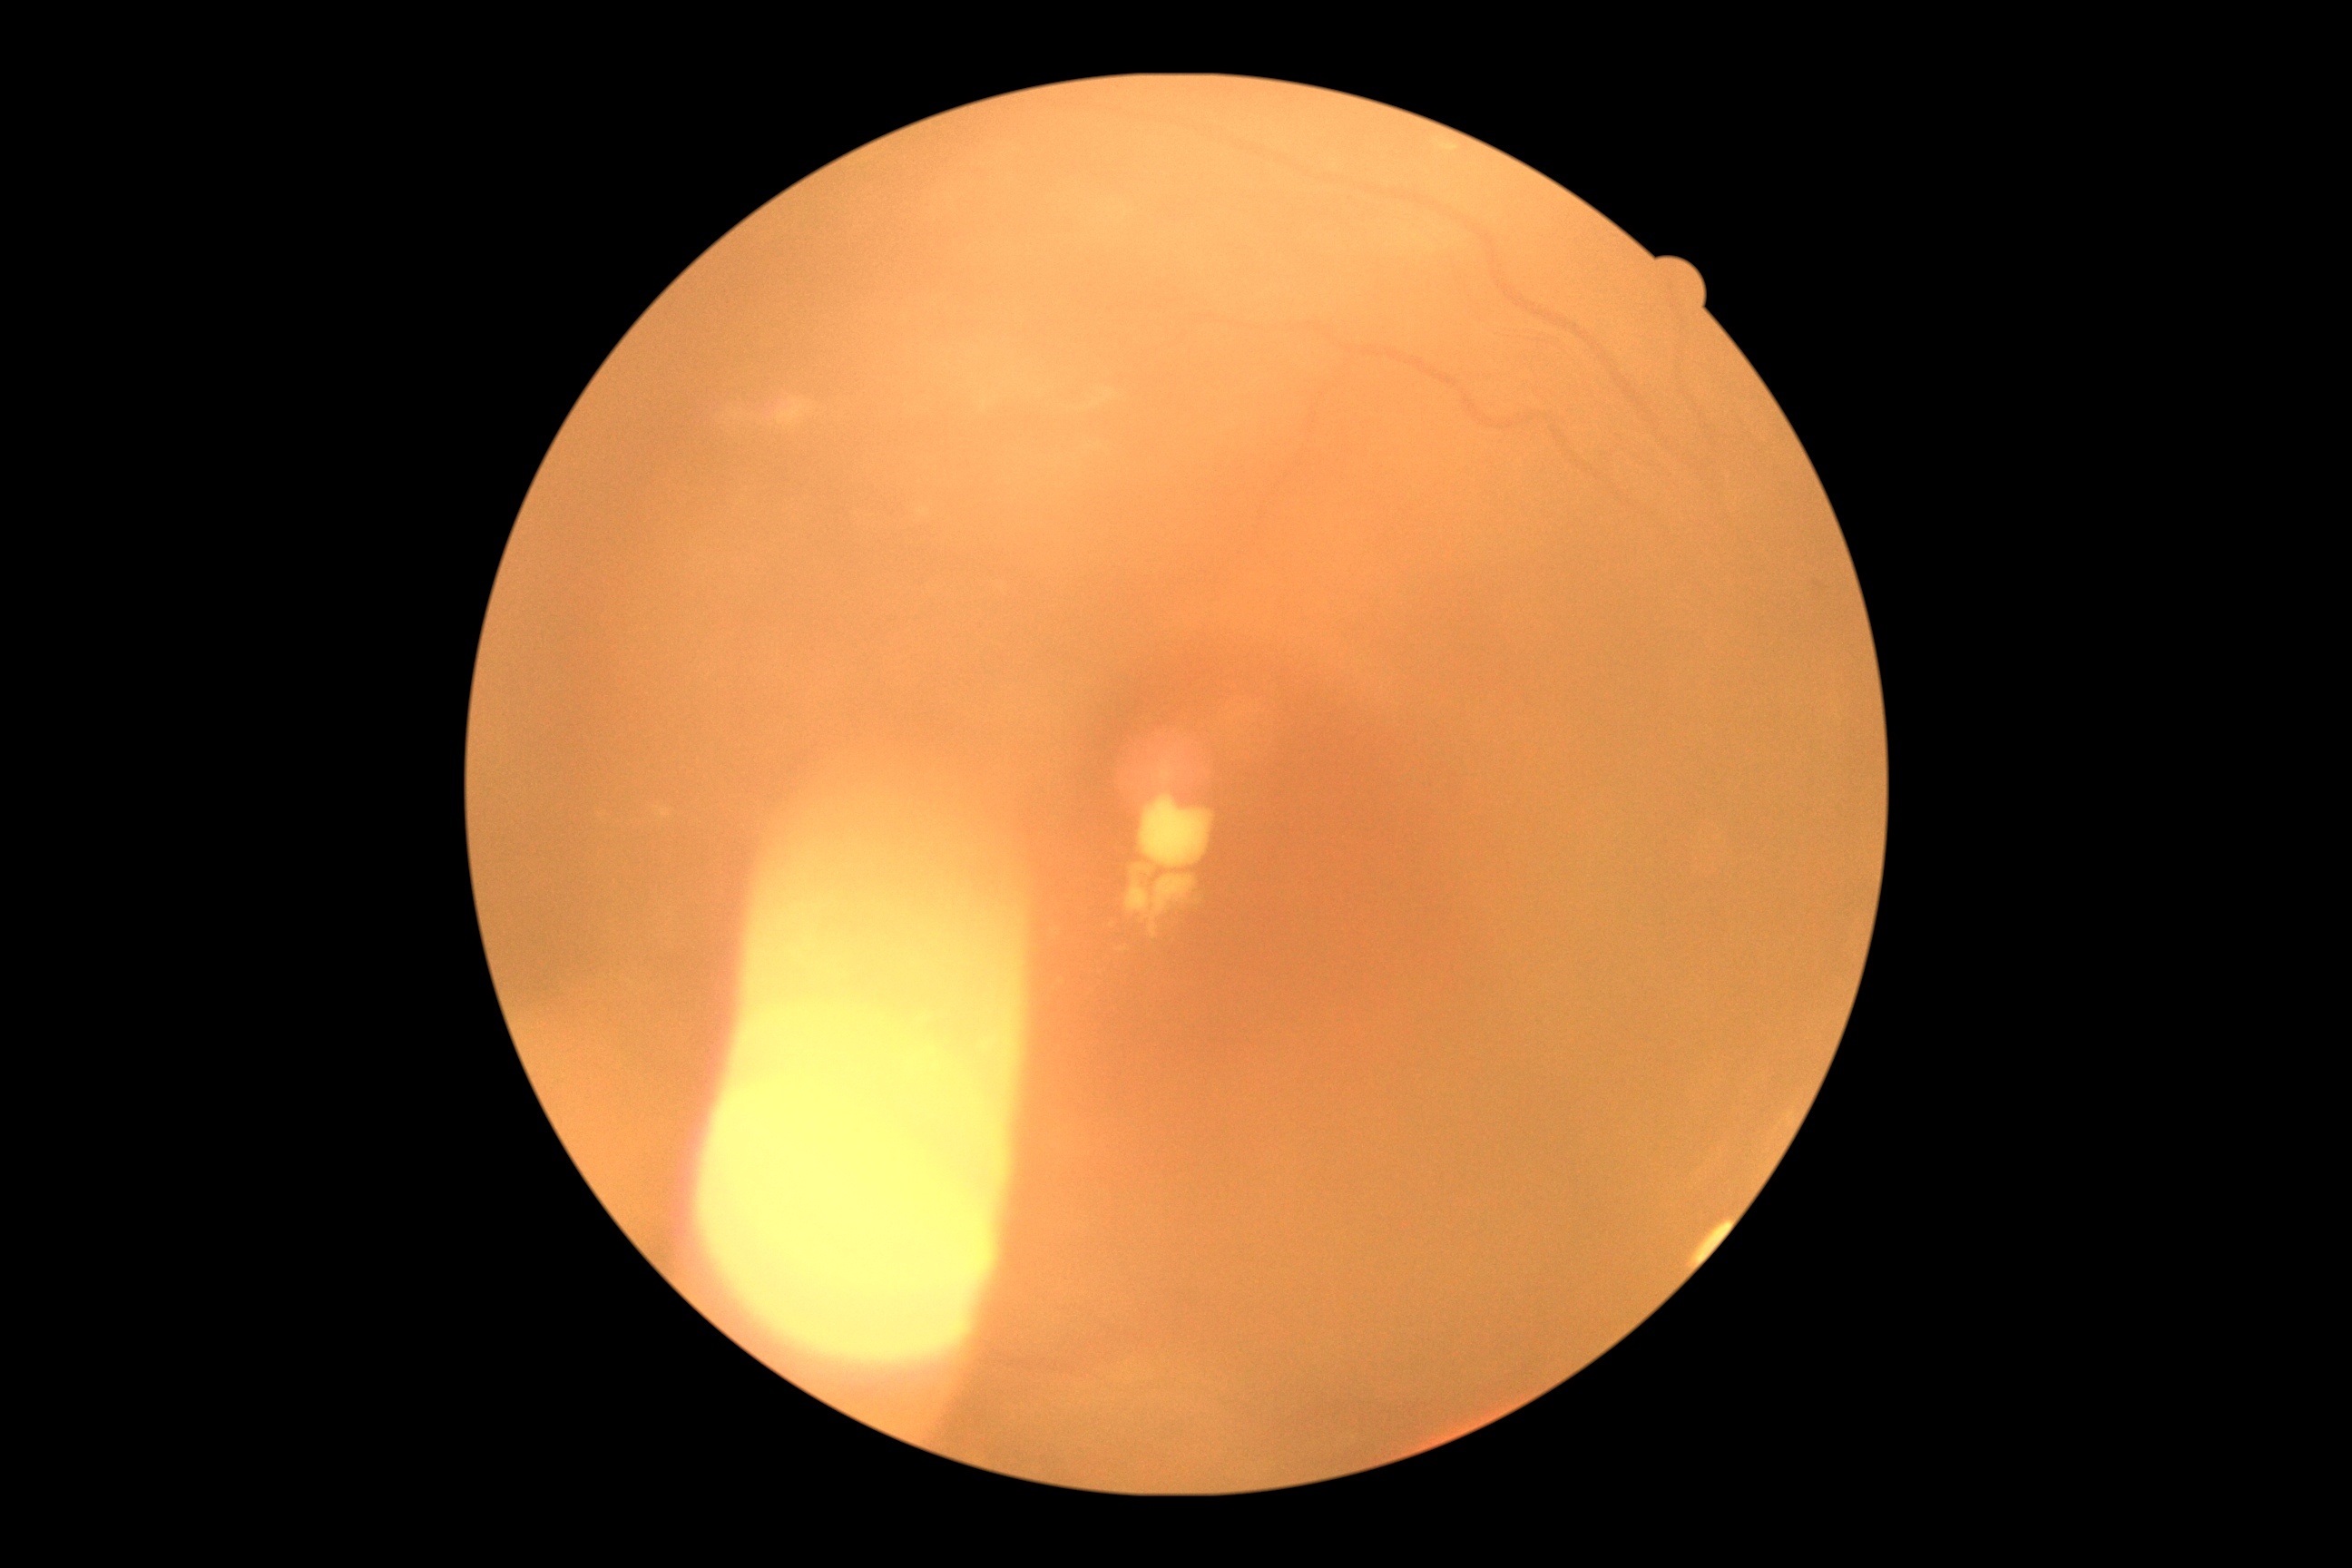 • diabetic retinopathy severity — grade 2 (moderate NPDR)
• DR class — non-proliferative diabetic retinopathy